Davis DR grading. Acquired with a NIDEK AFC-230. Nonmydriatic fundus photograph
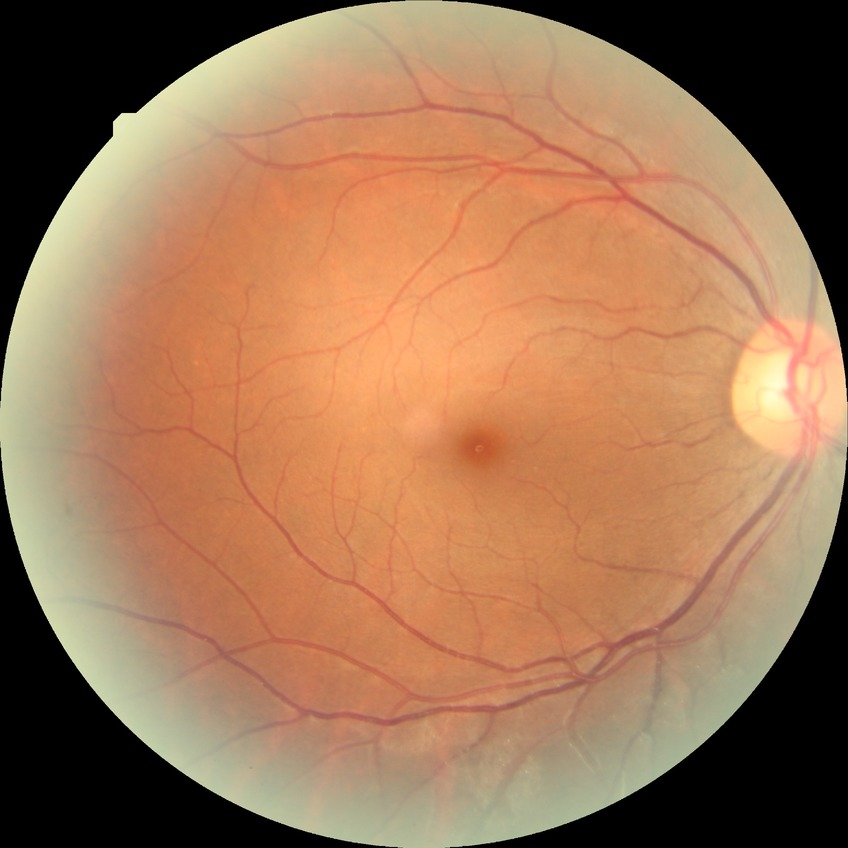

DR impression=no DR findings, DR severity=NDR.